Captured without pupil dilation:
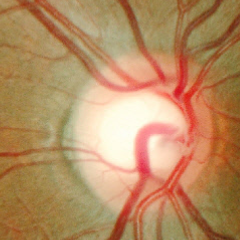
No signs of glaucoma.